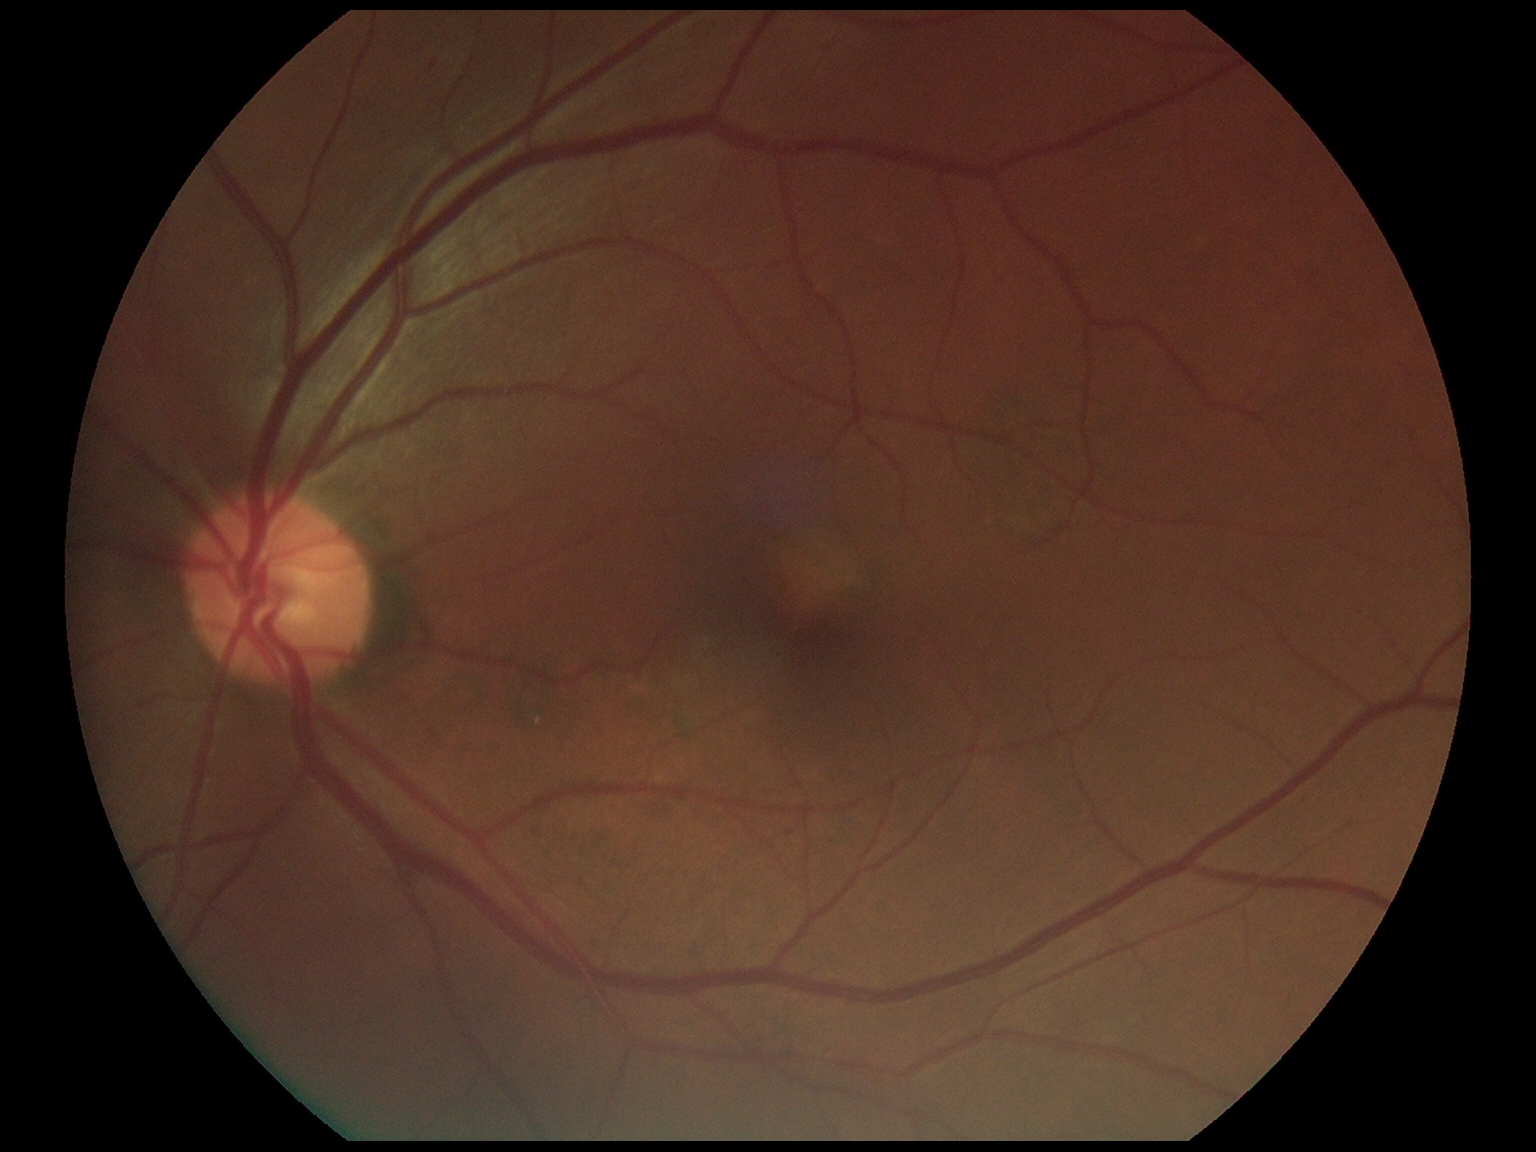

  dr_grade: 1
  dr_category: non-proliferative diabetic retinopathy